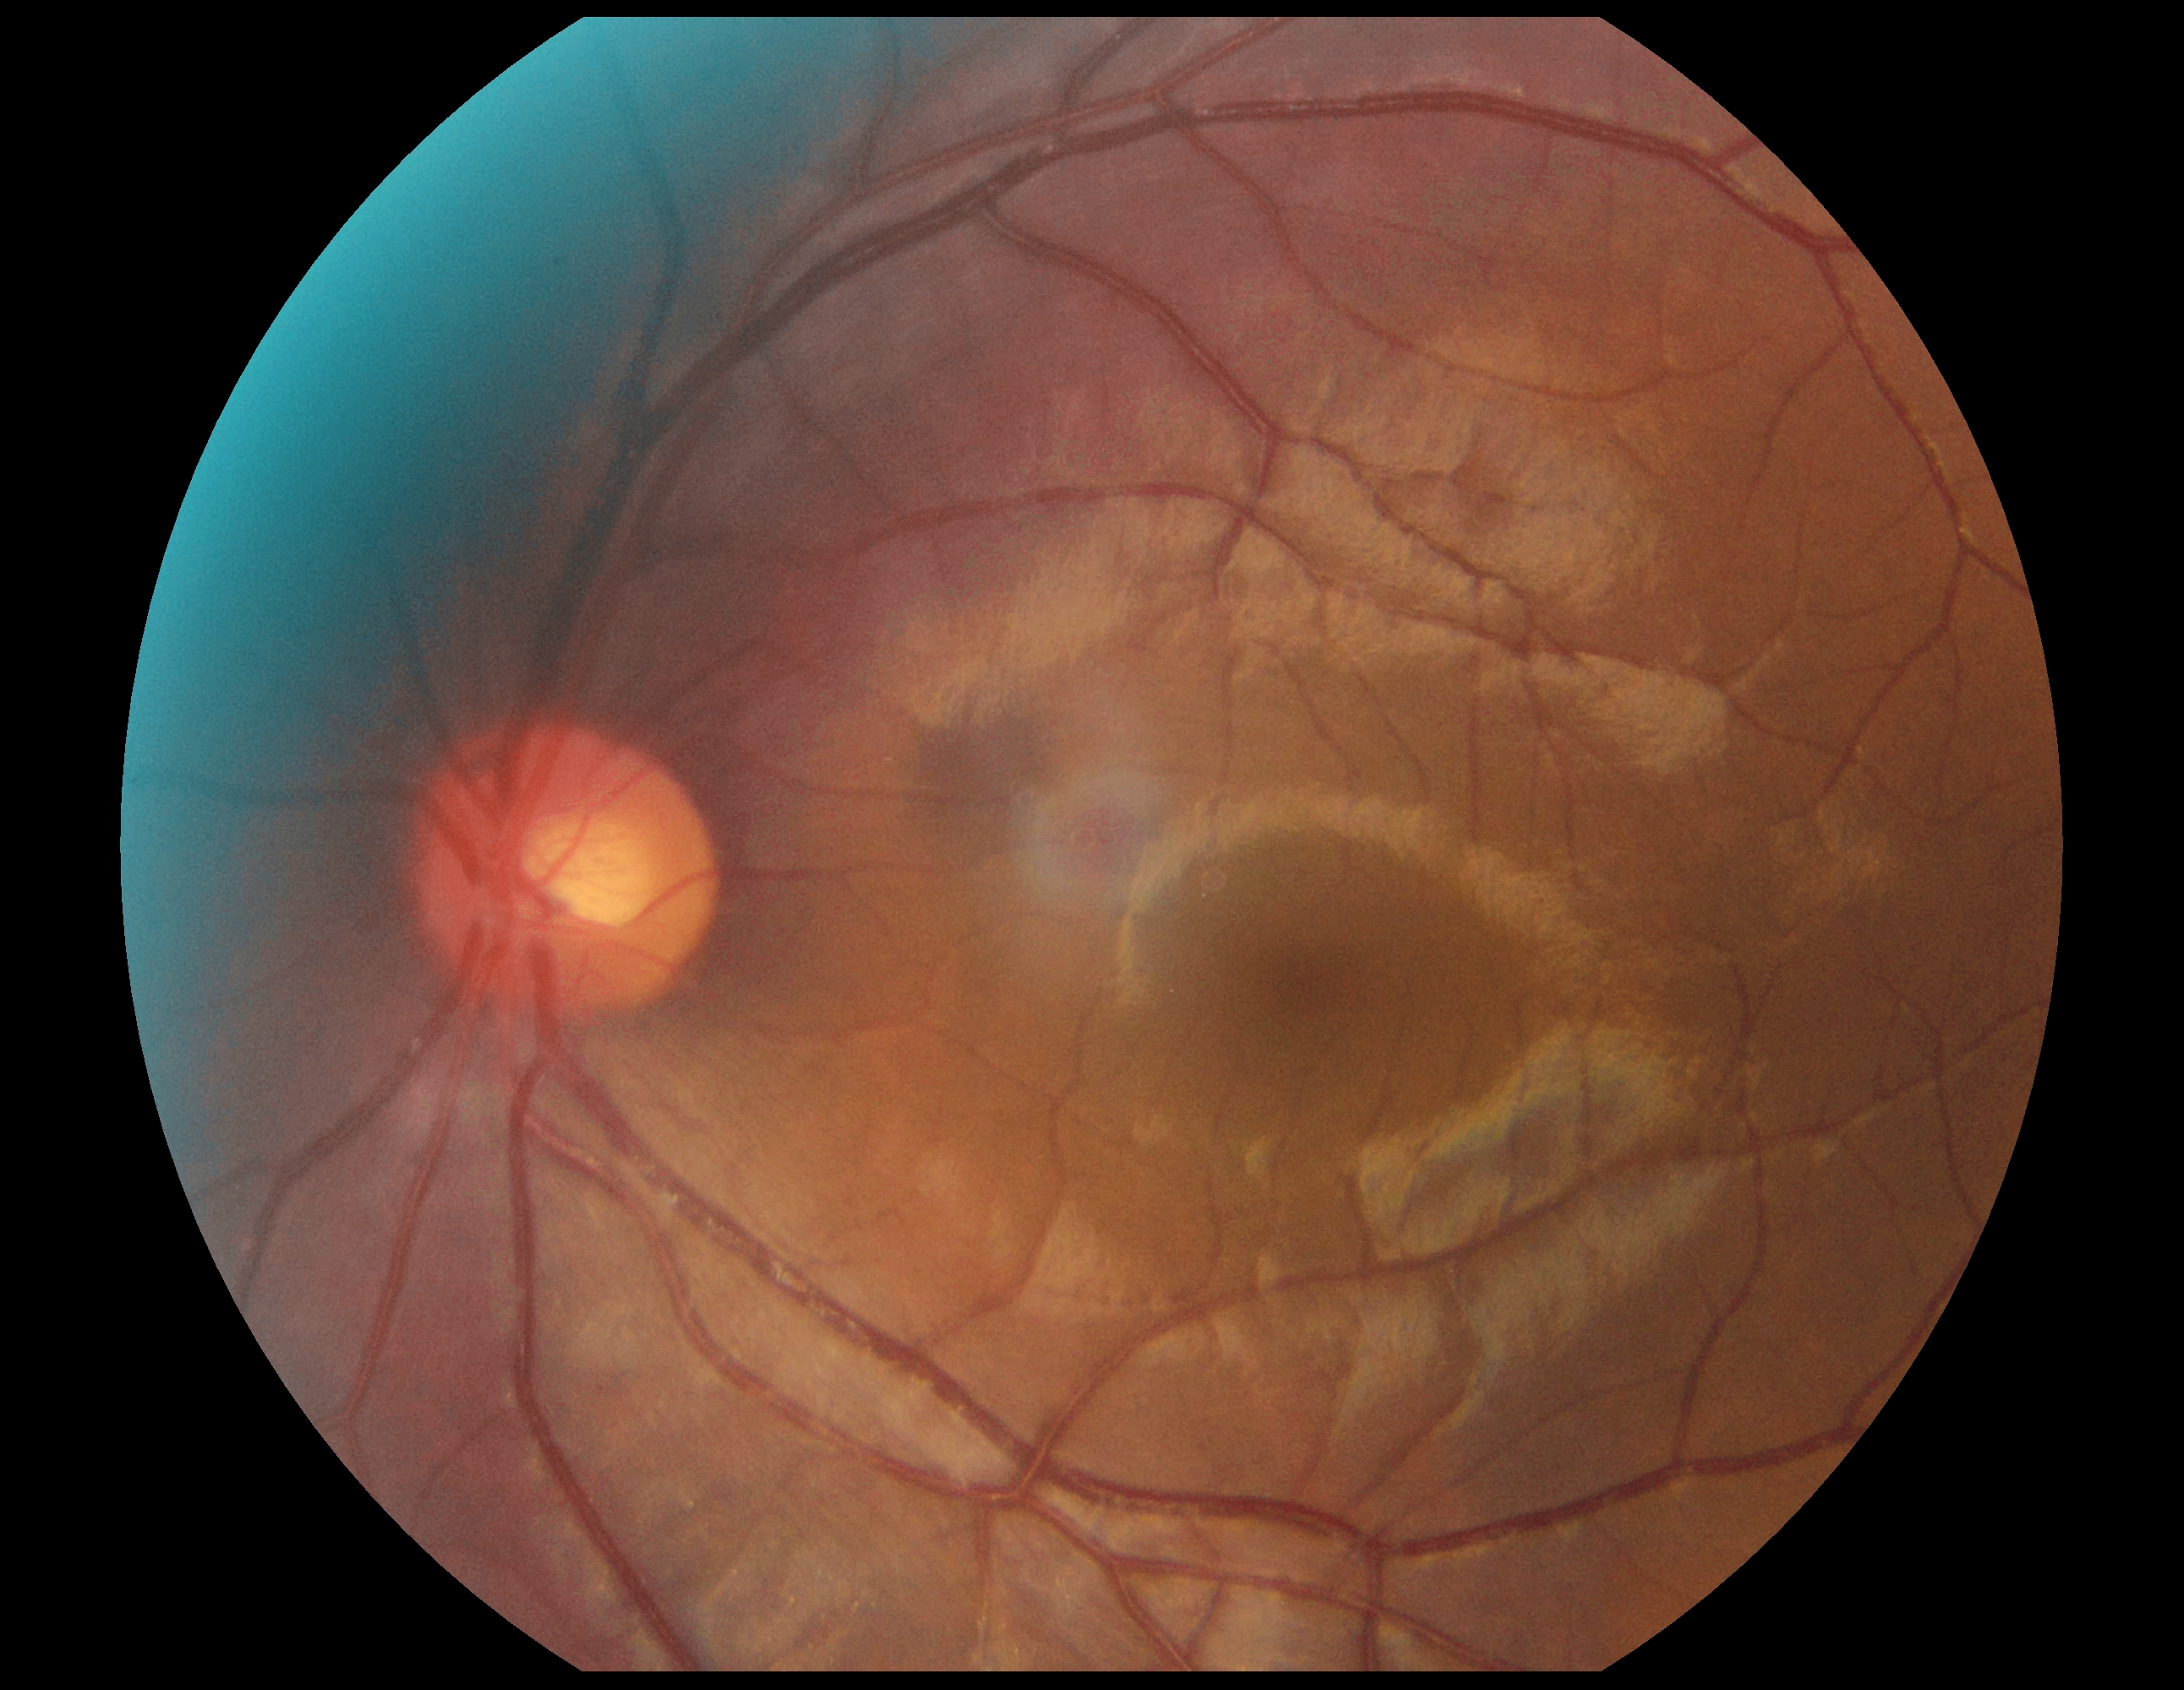 Diabetic retinopathy (DR) is no apparent diabetic retinopathy (grade 0) — no visible signs of diabetic retinopathy. No diabetic retinal disease findings.